Pediatric wide-field fundus photograph
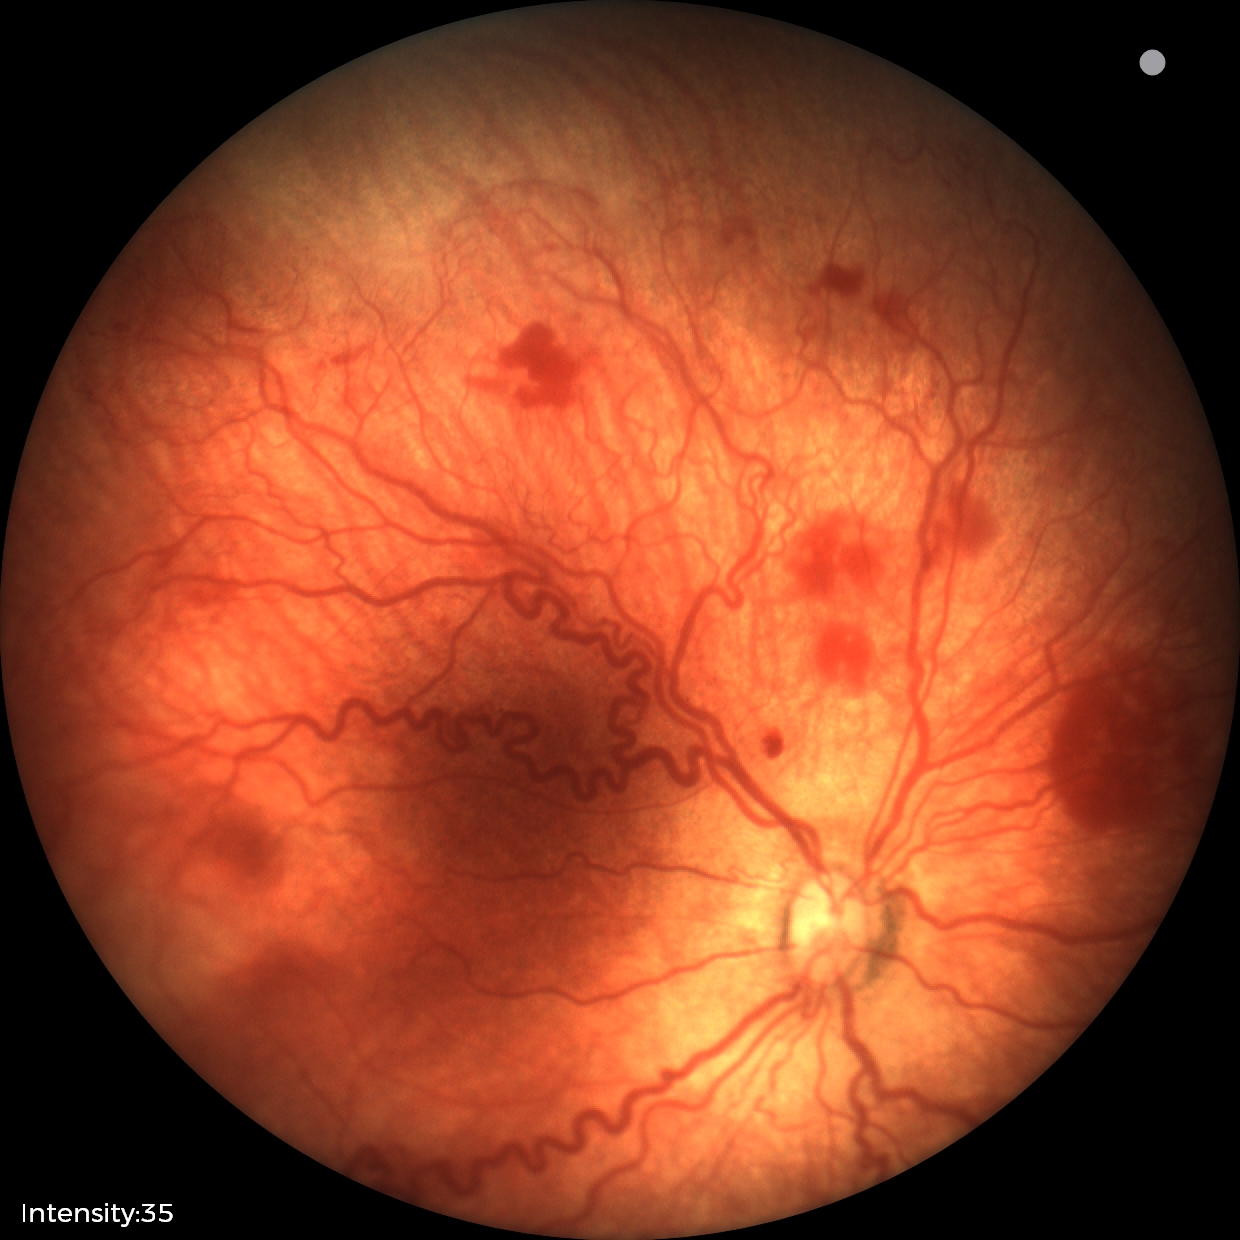 From an examination with diagnosis of ROP stage 2. Plus disease present.